100° field of view (Phoenix ICON); wide-field fundus image from infant ROP screening
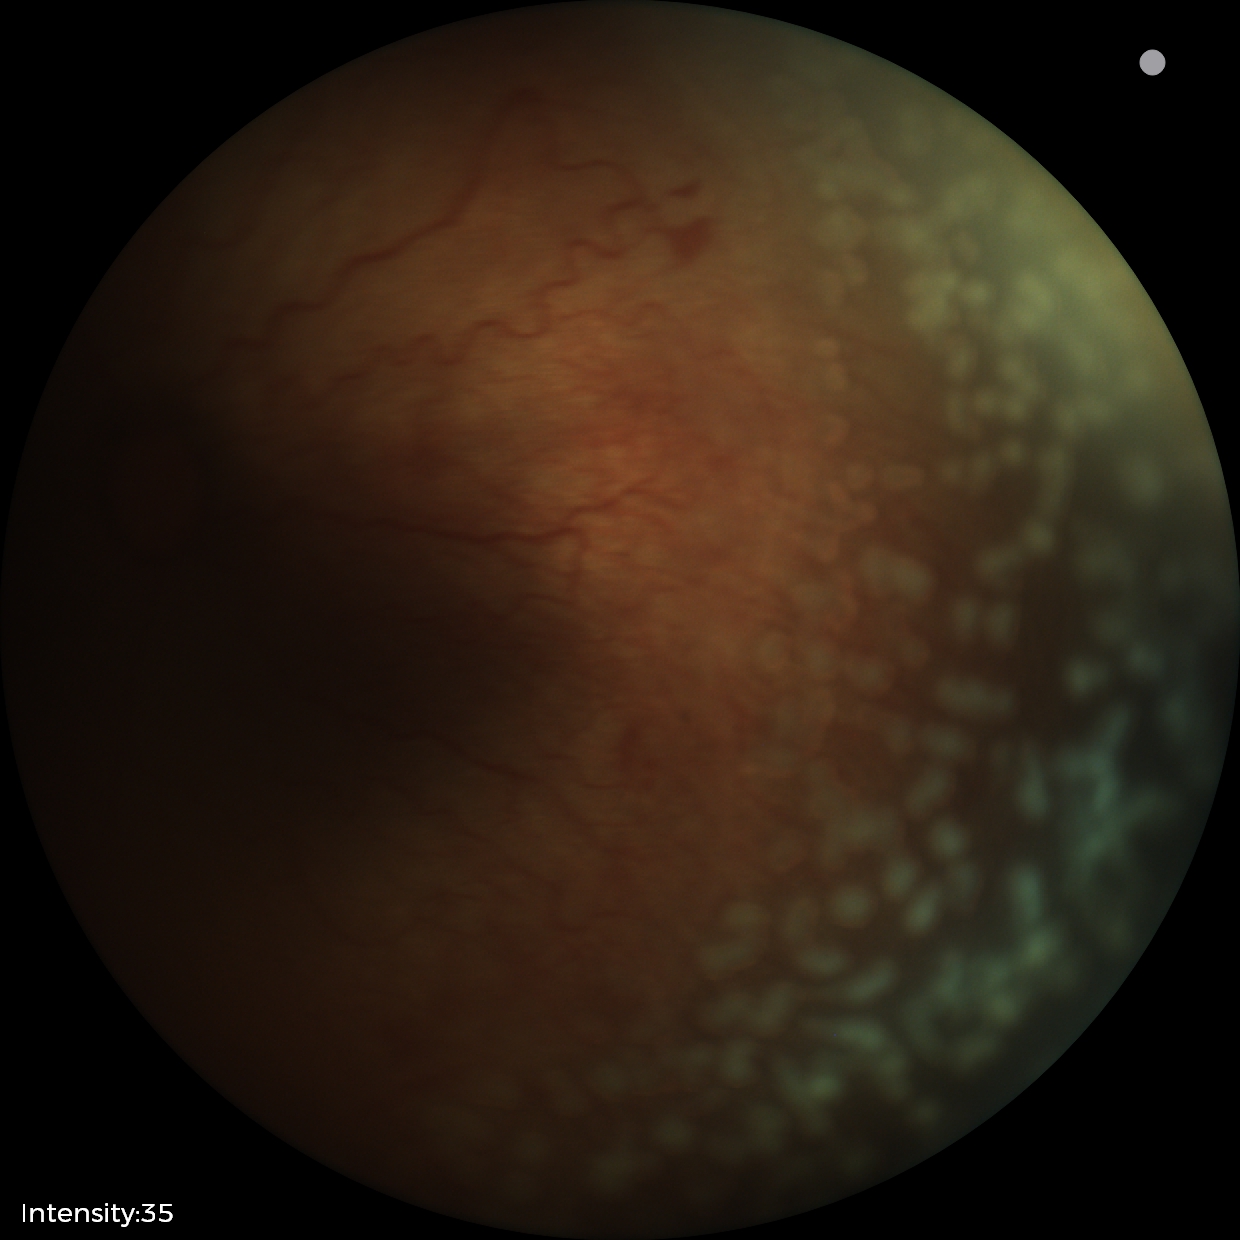
Plus disease present. Screening examination consistent with retinopathy of prematurity stage 2.